2048 by 1536 pixels
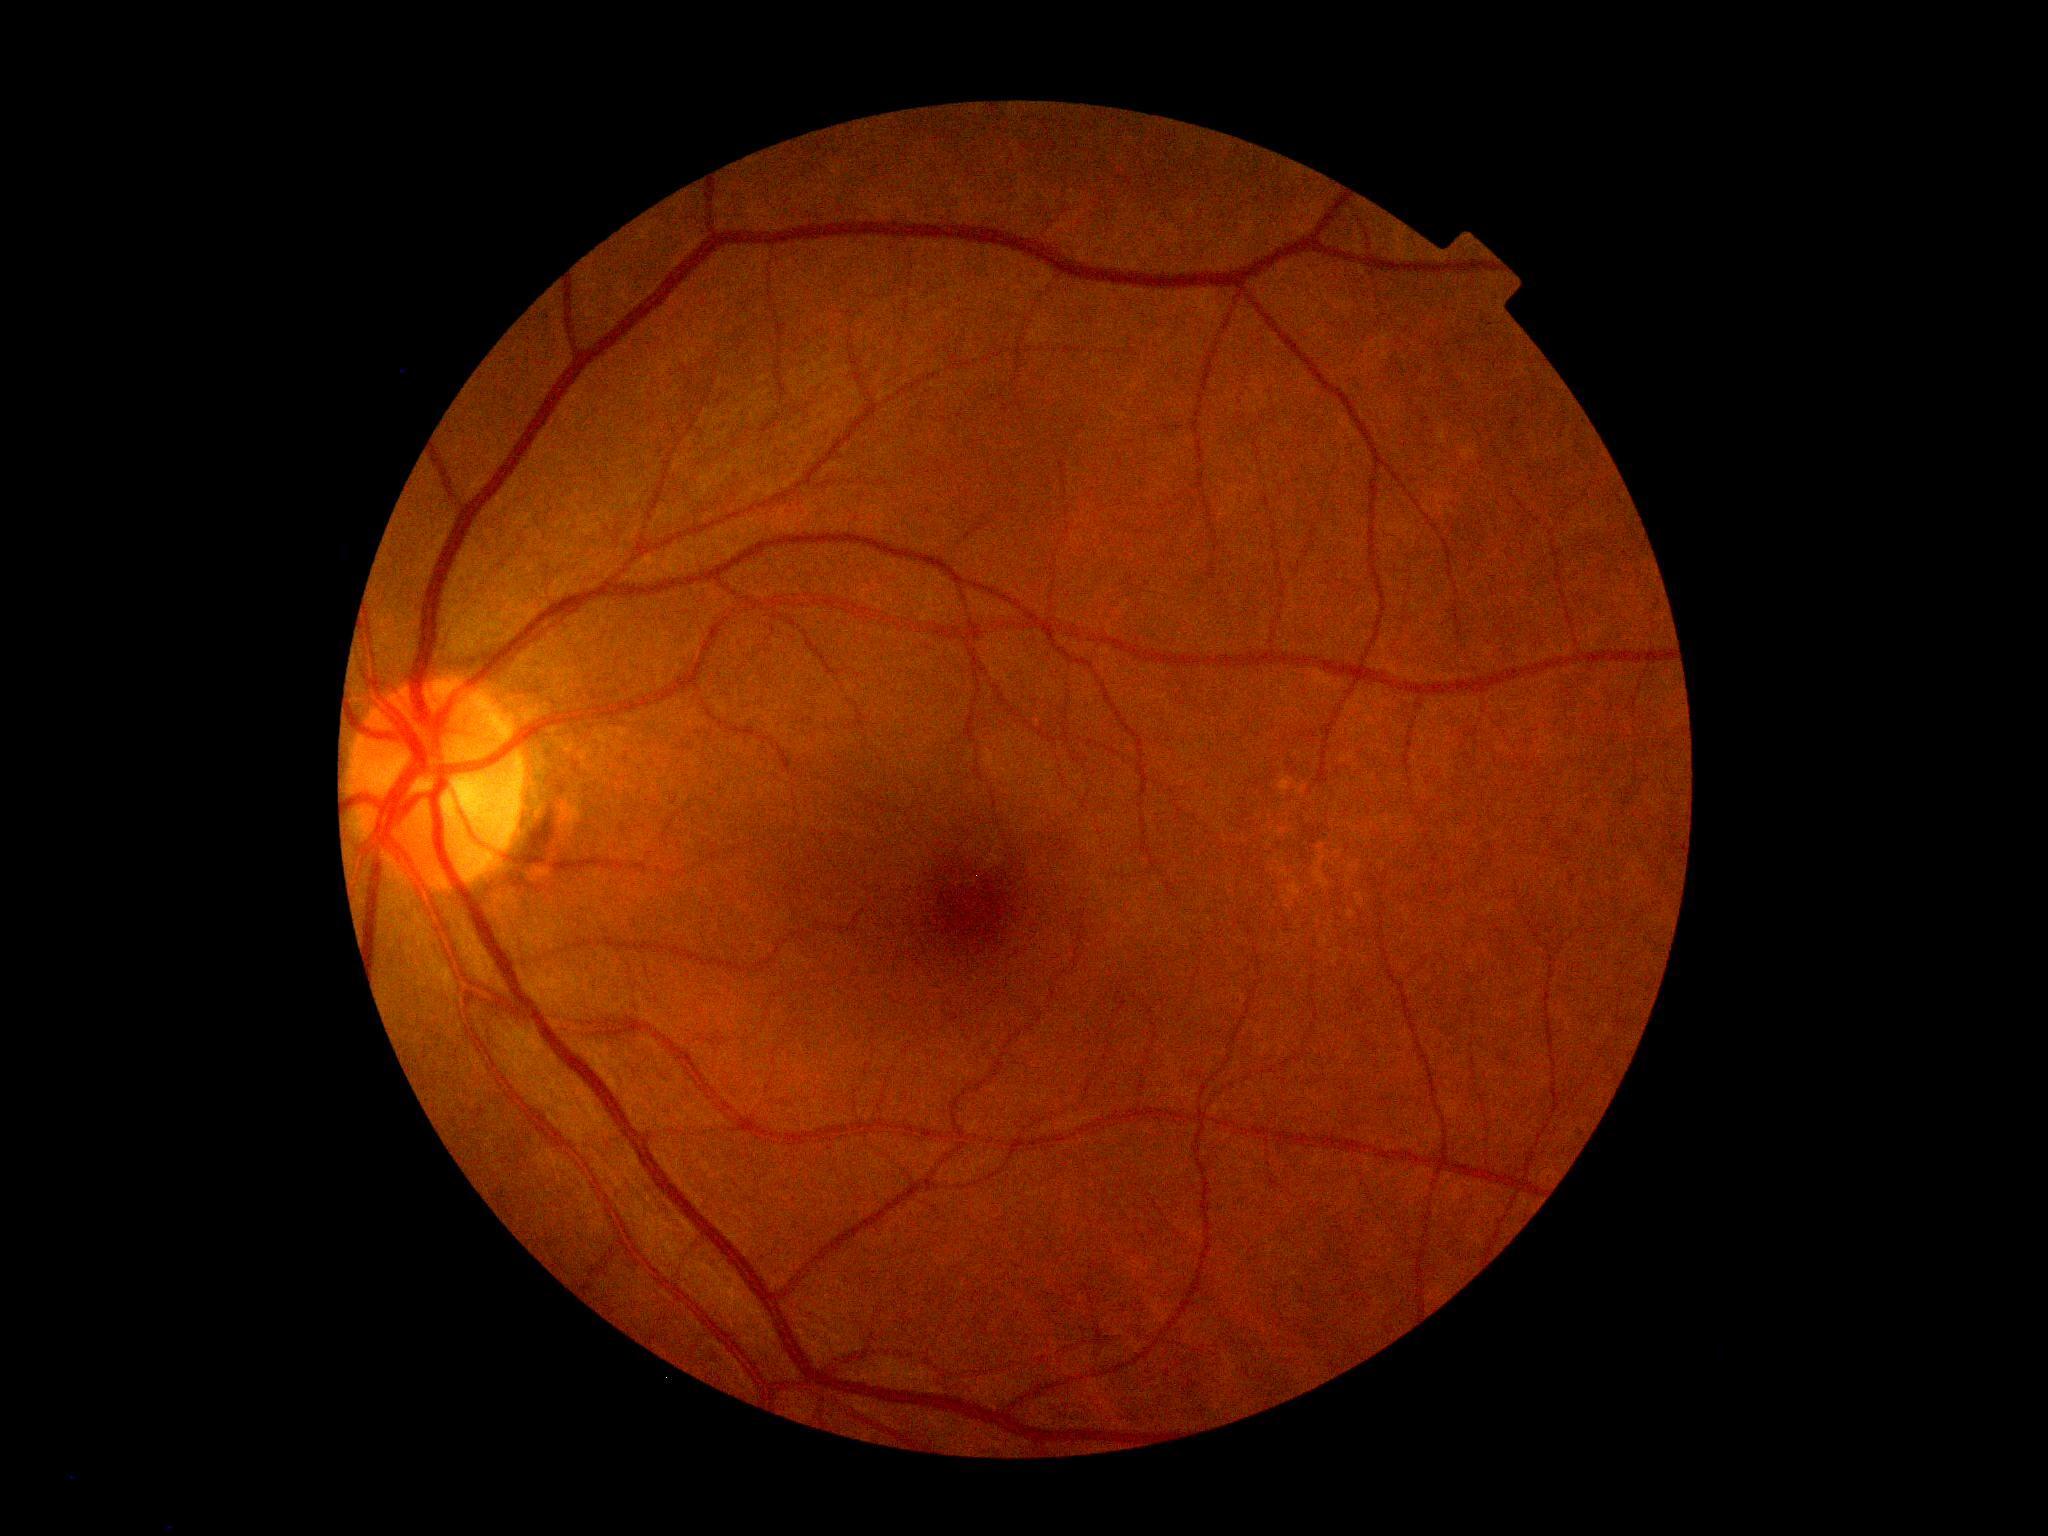 DR grade: 0.